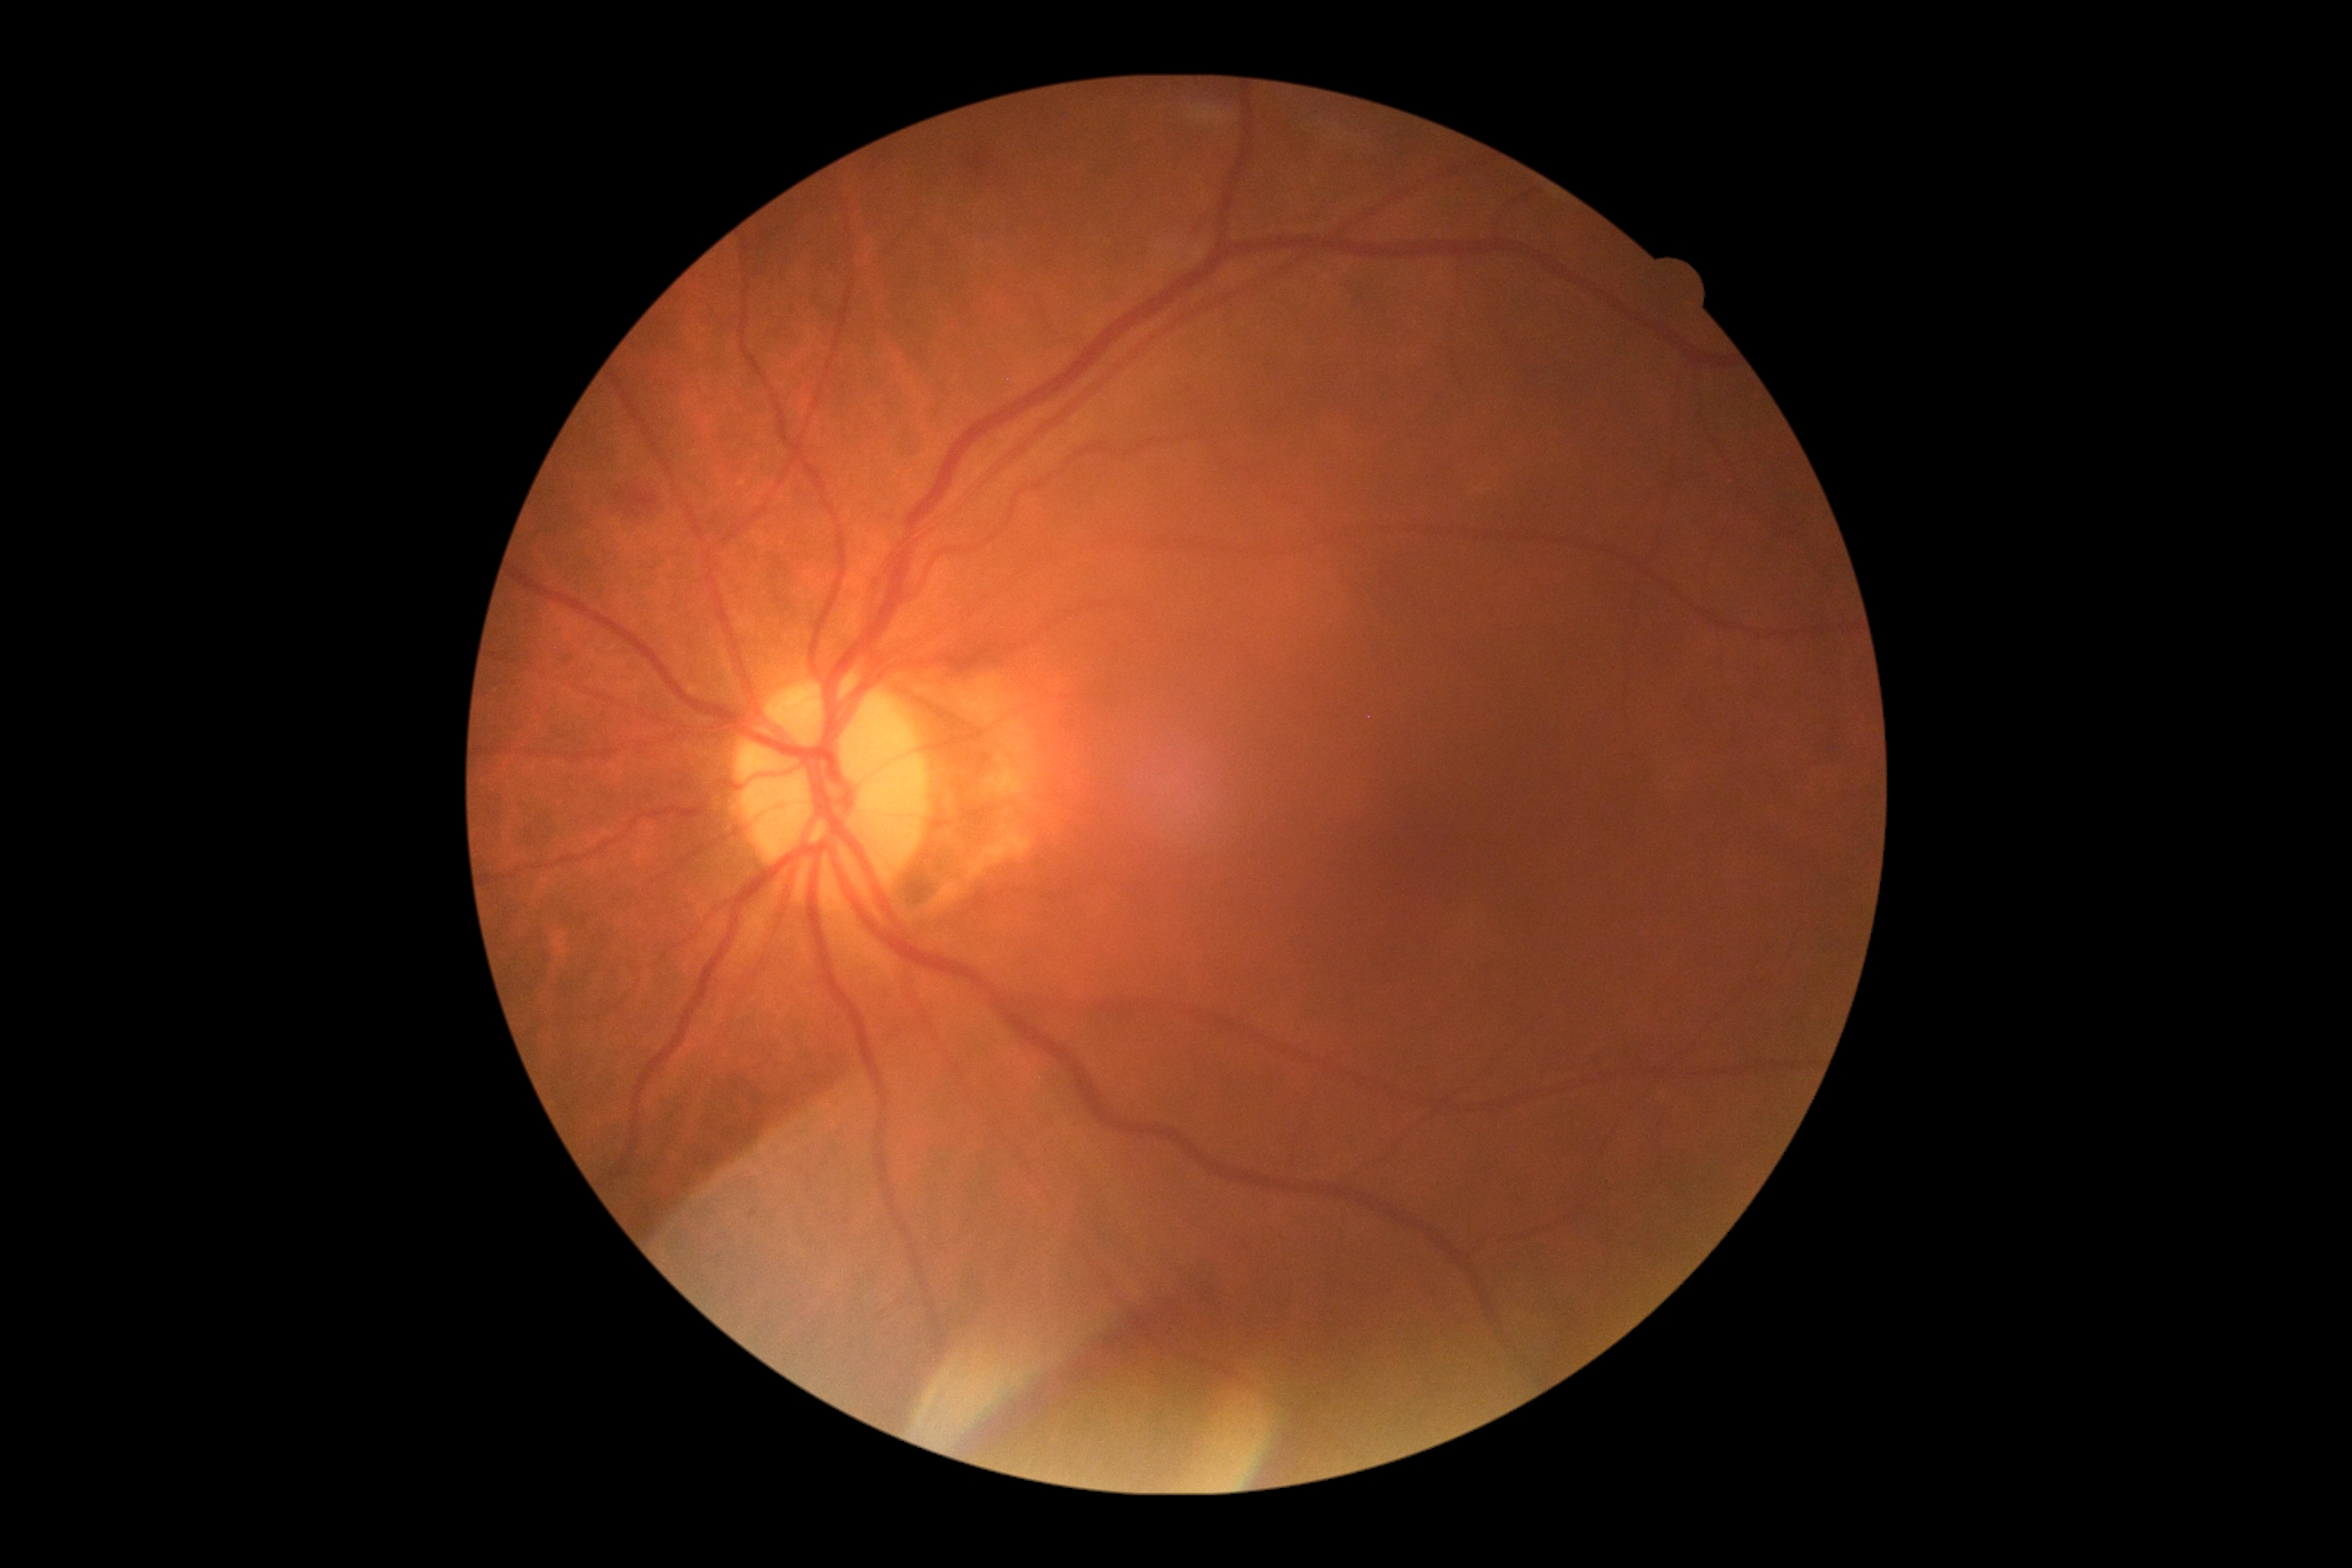 DR stage: 2/4.